640 x 480 pixels; pediatric retinal photograph (wide-field): 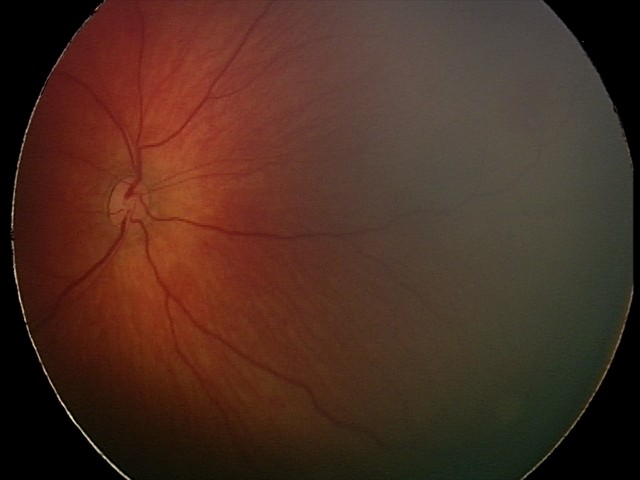

Screening series with retinal hemorrhages.